Camera: Remidio smartphone fundus camera · image size 1659x2212 · color fundus image — 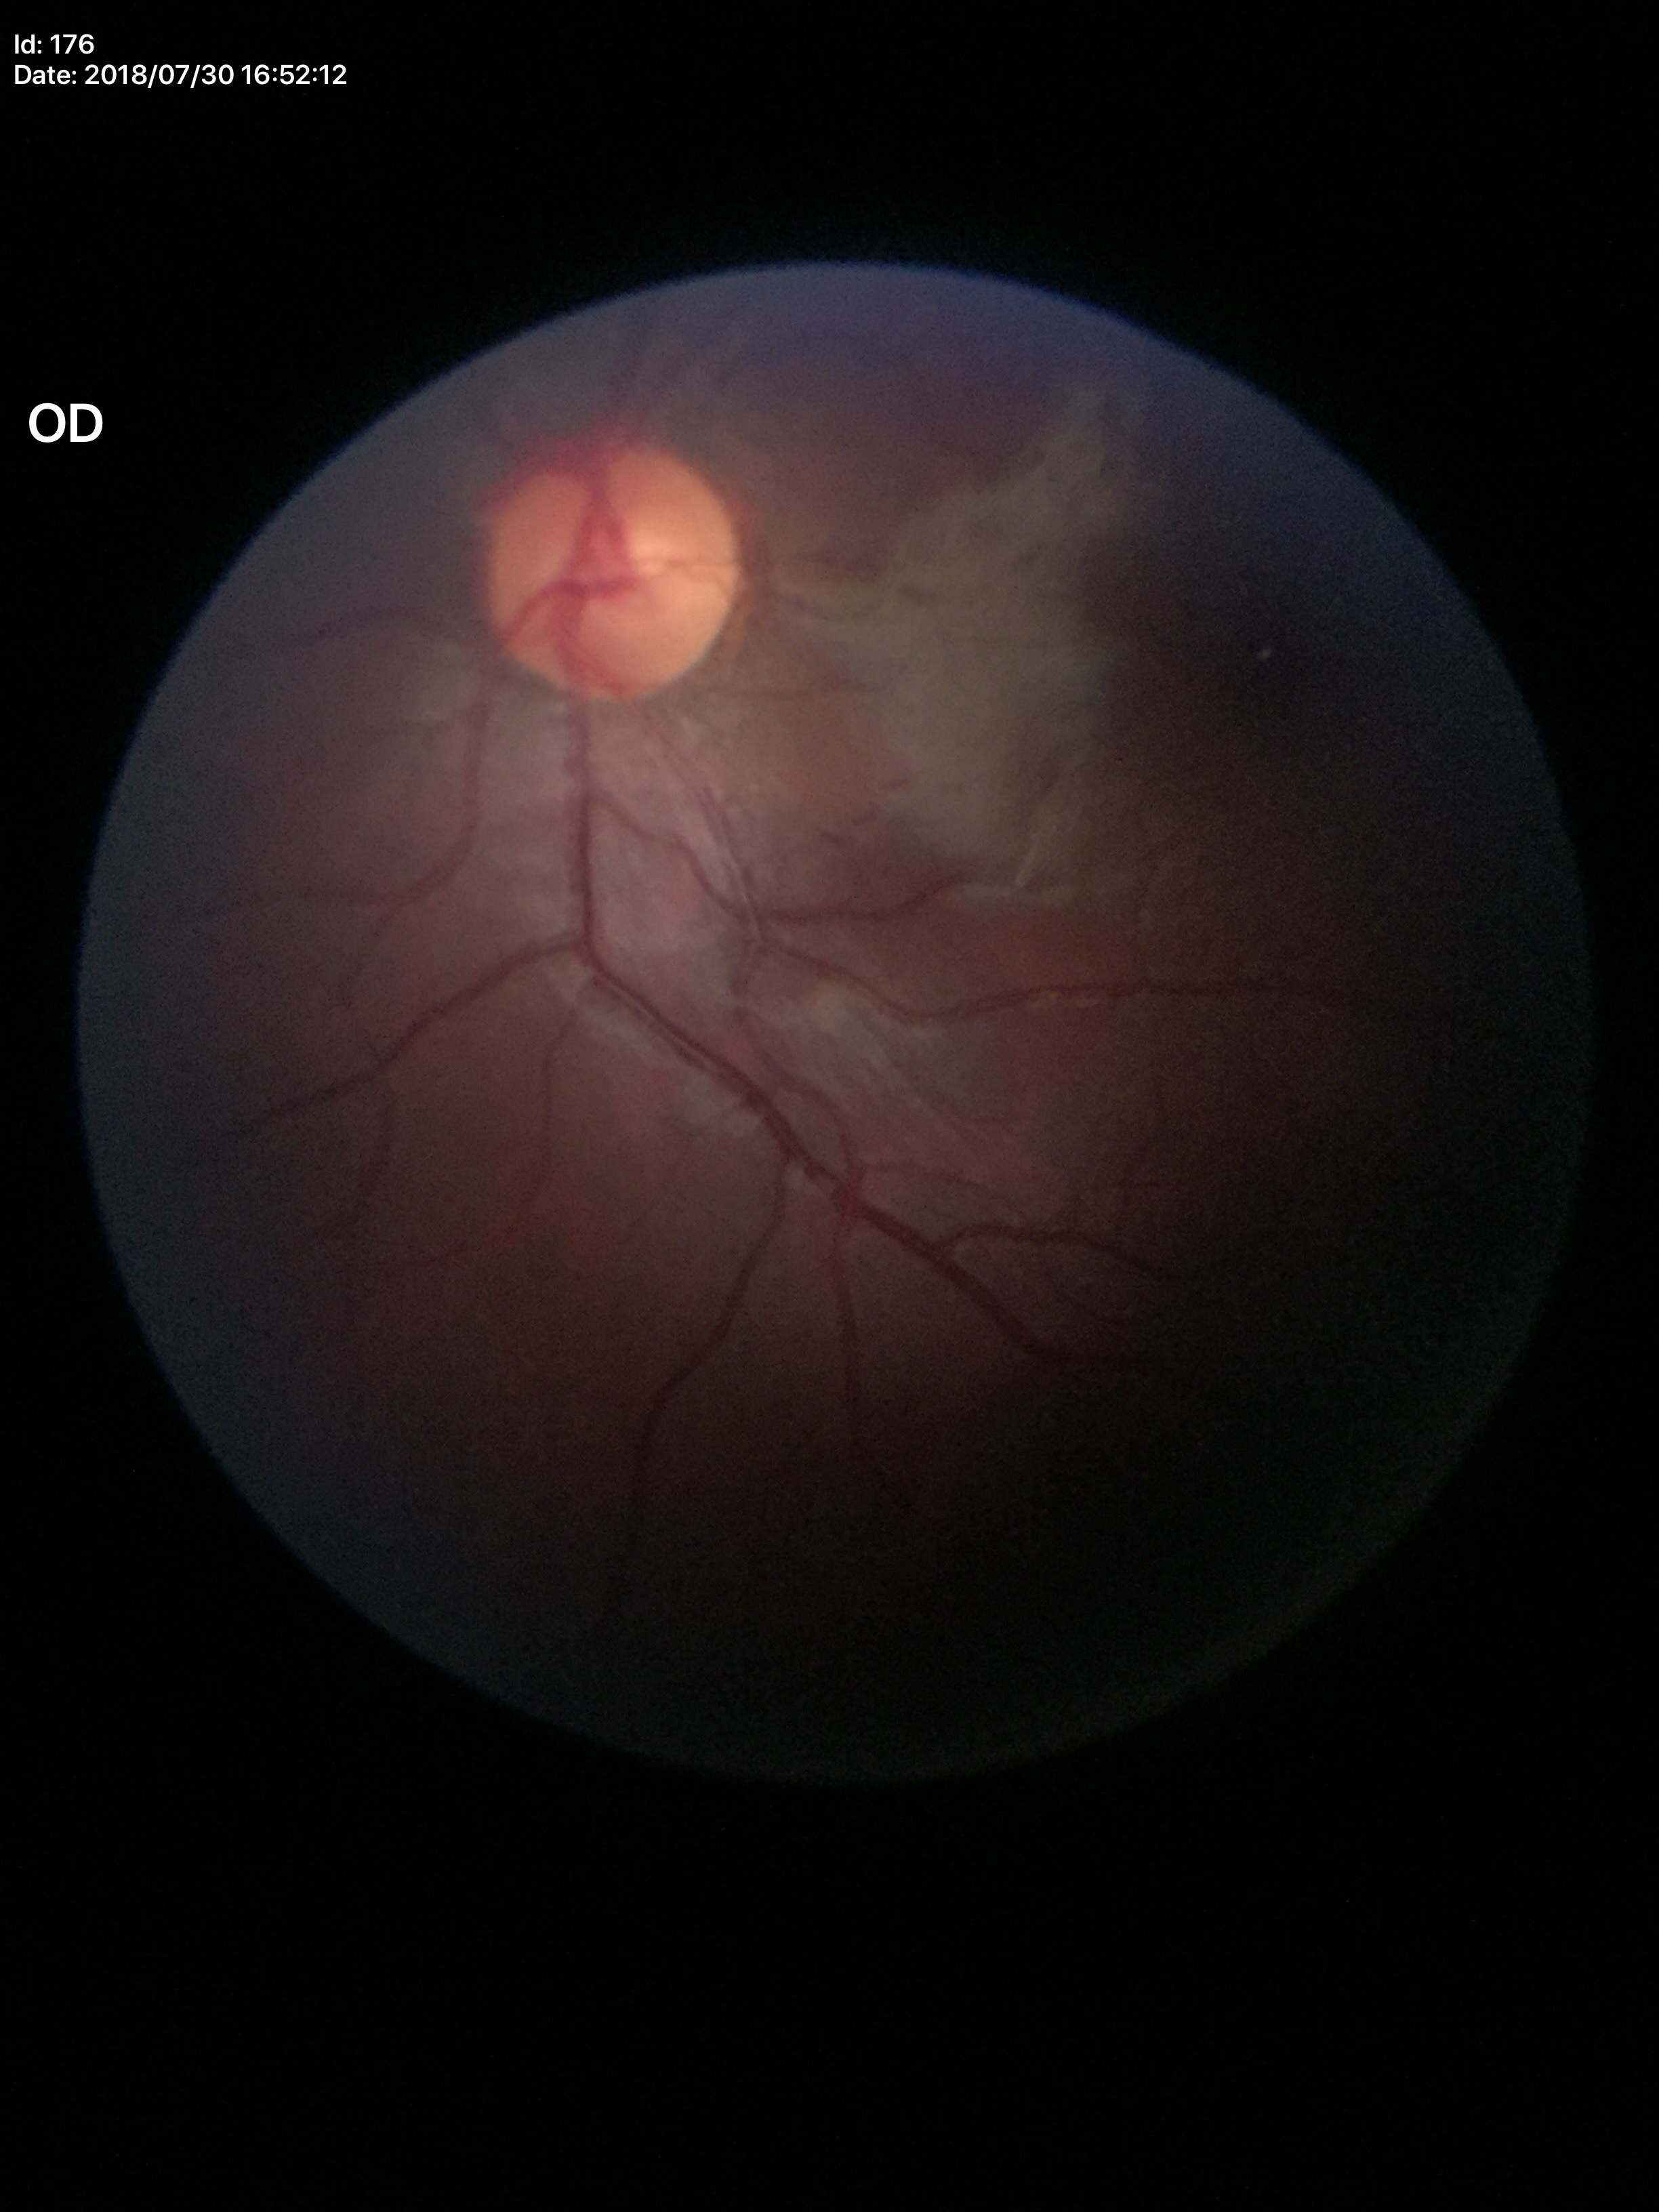 Glaucoma evaluation: negative.
Vertical cup-disc ratio of 0.47.